640 x 480 pixels; camera: Clarity RetCam 3 (130° FOV); wide-field fundus photograph from neonatal ROP screening — 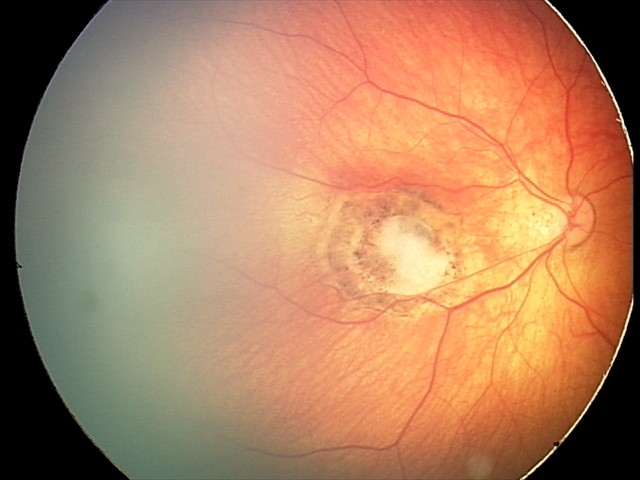 Screening examination consistent with toxoplasmosis chorioretinitis.